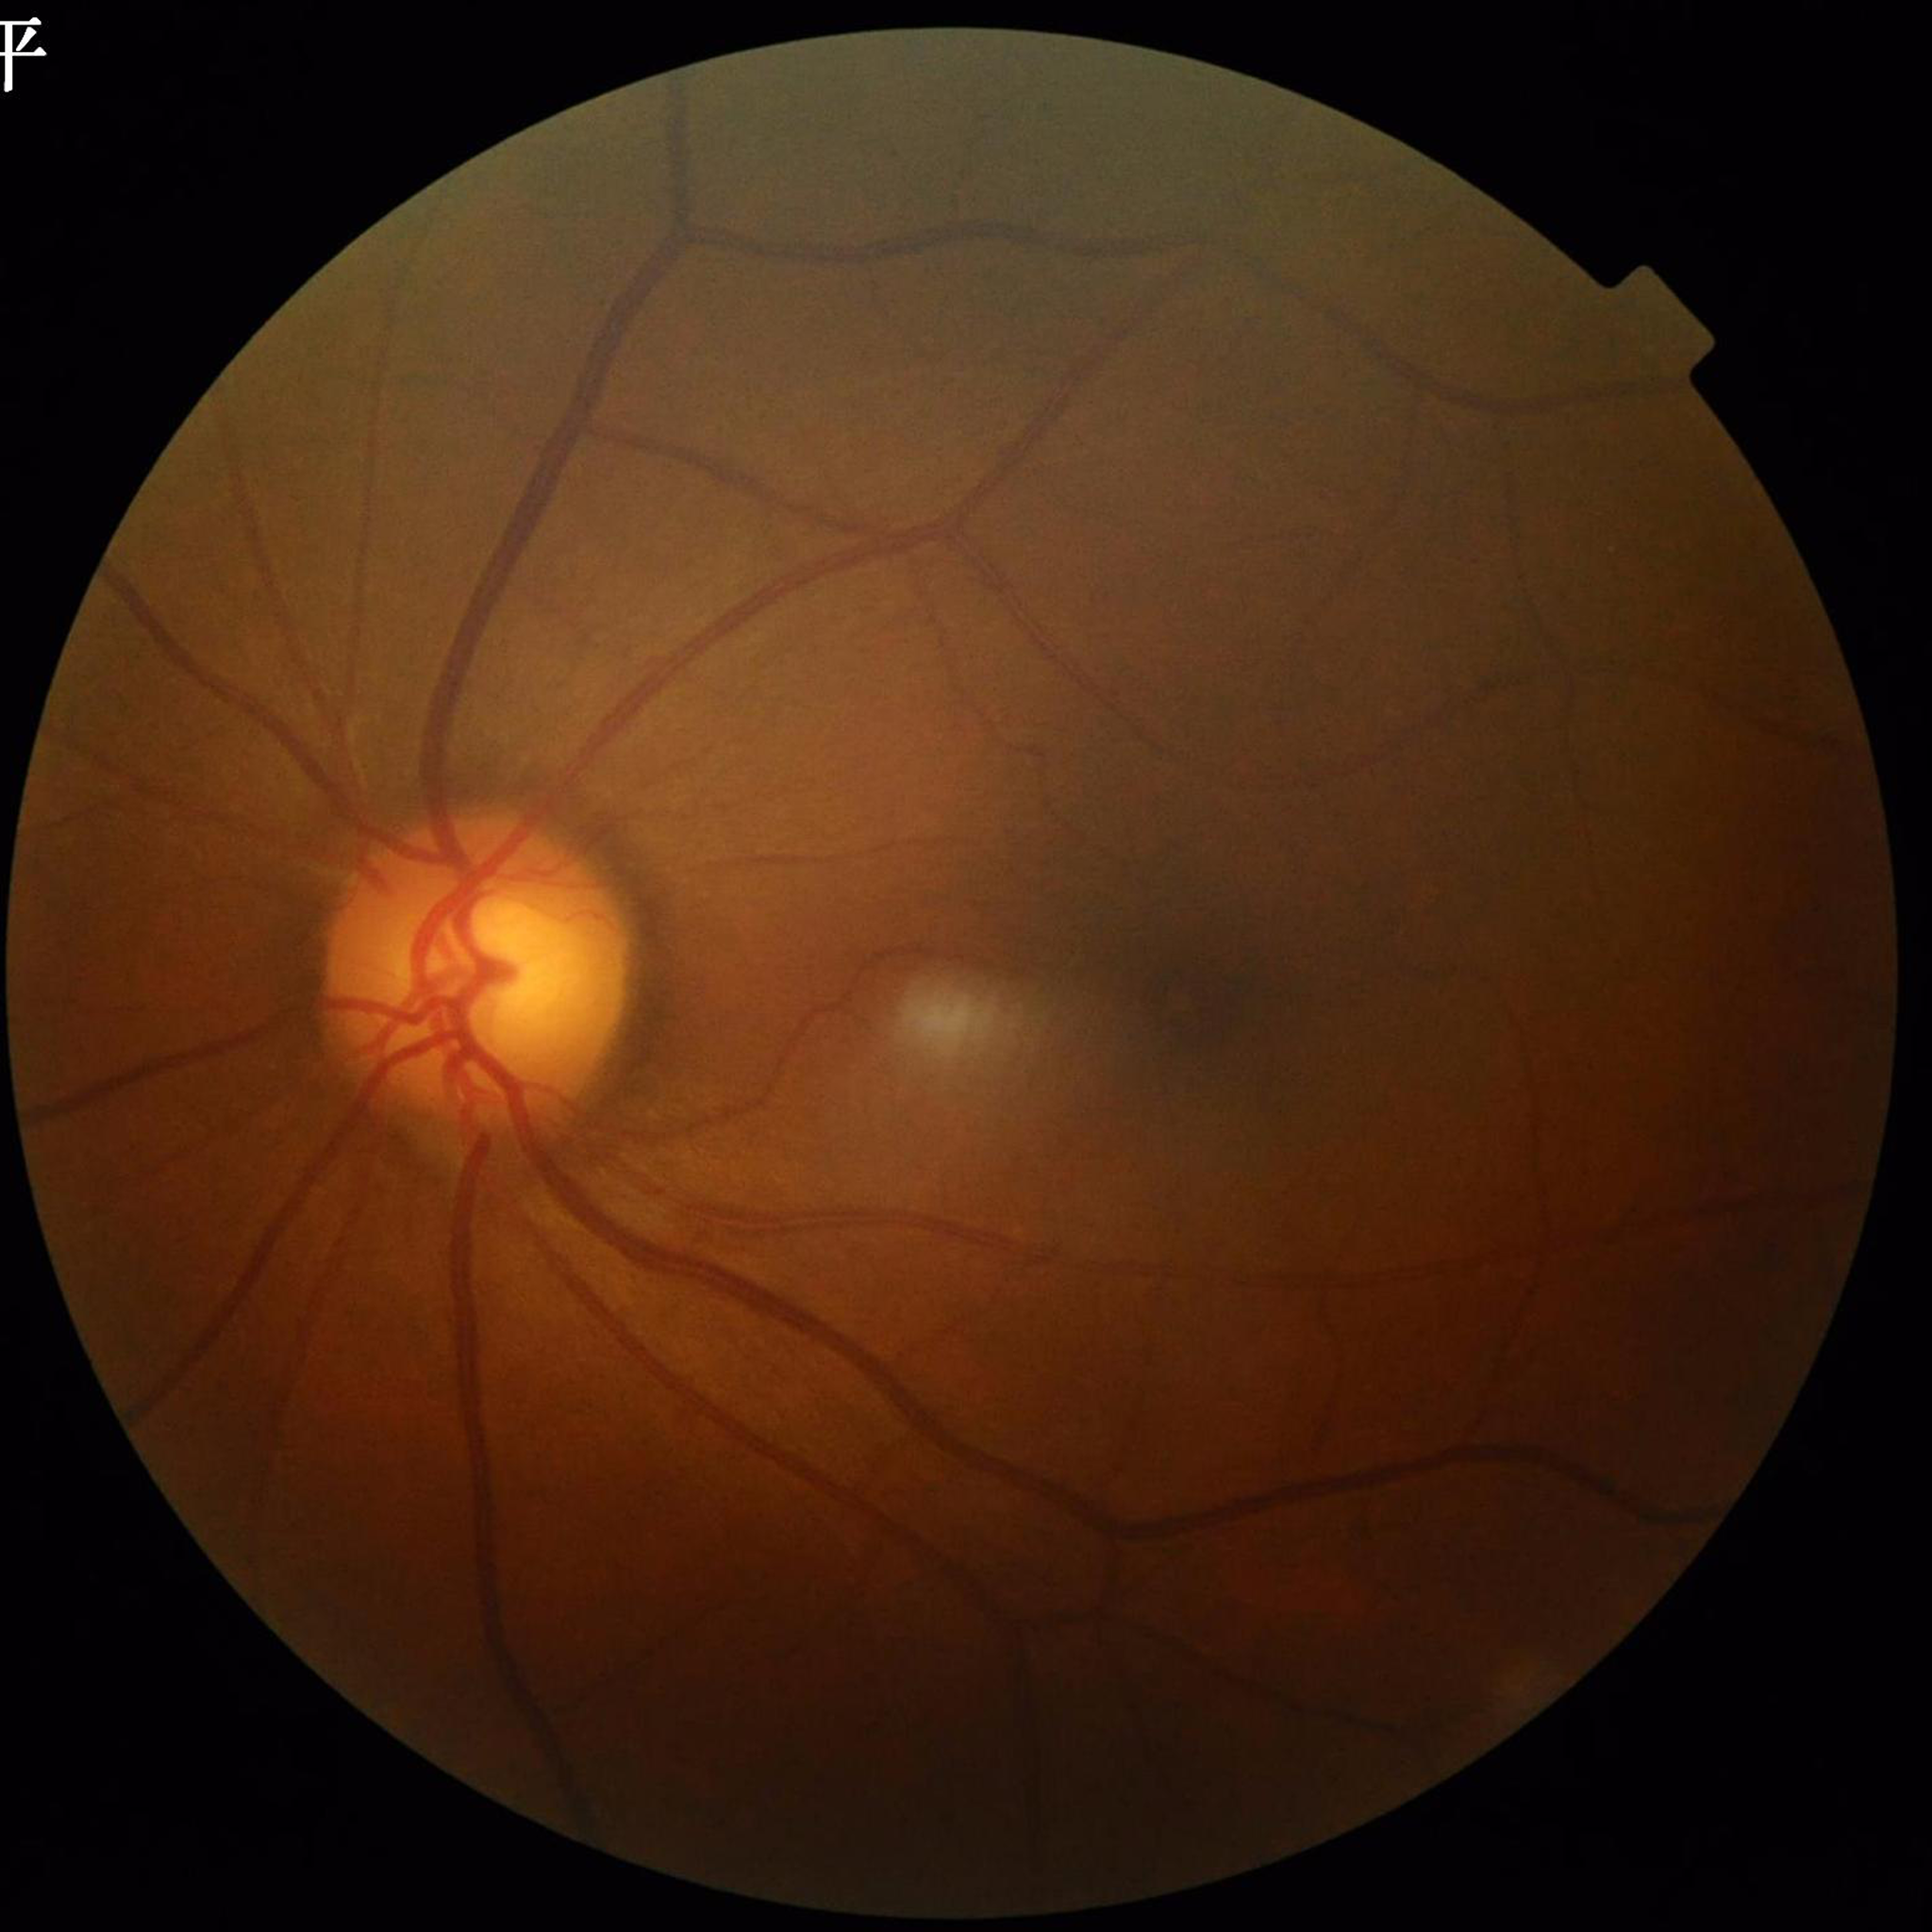
diagnosis: glaucoma
image_quality: poor — illumination/color distortion